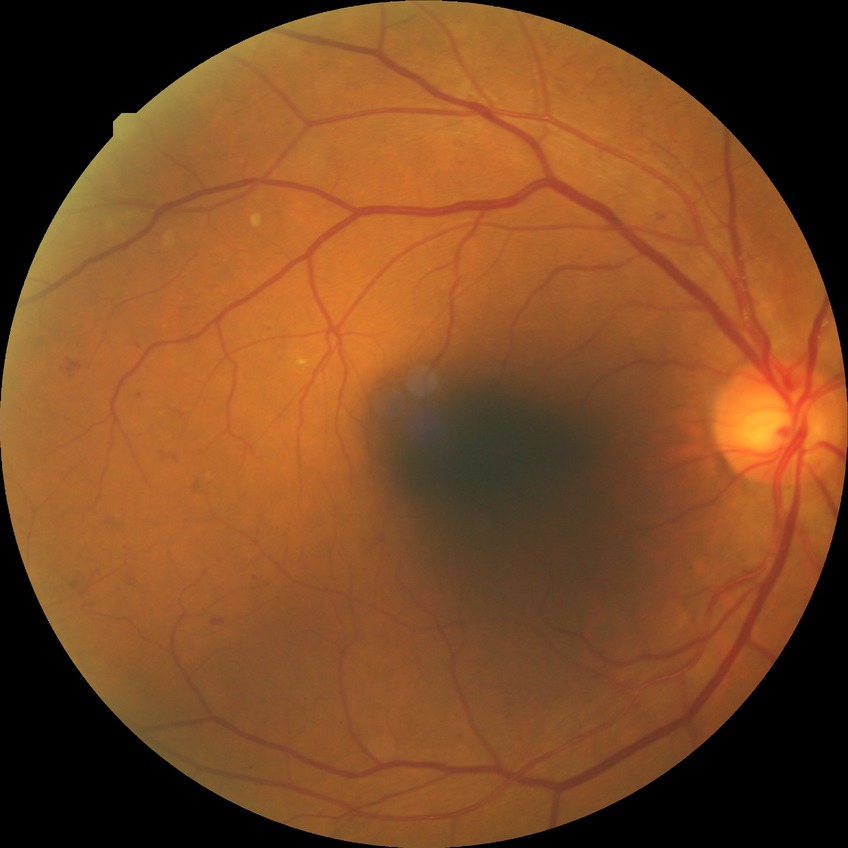

  davis_grade: pre-proliferative diabetic retinopathy